Image size 240x240 — 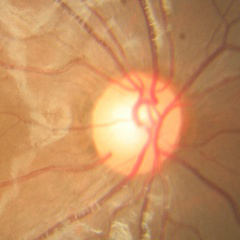

Q: What is the glaucoma diagnosis?
A: No glaucomatous findings.